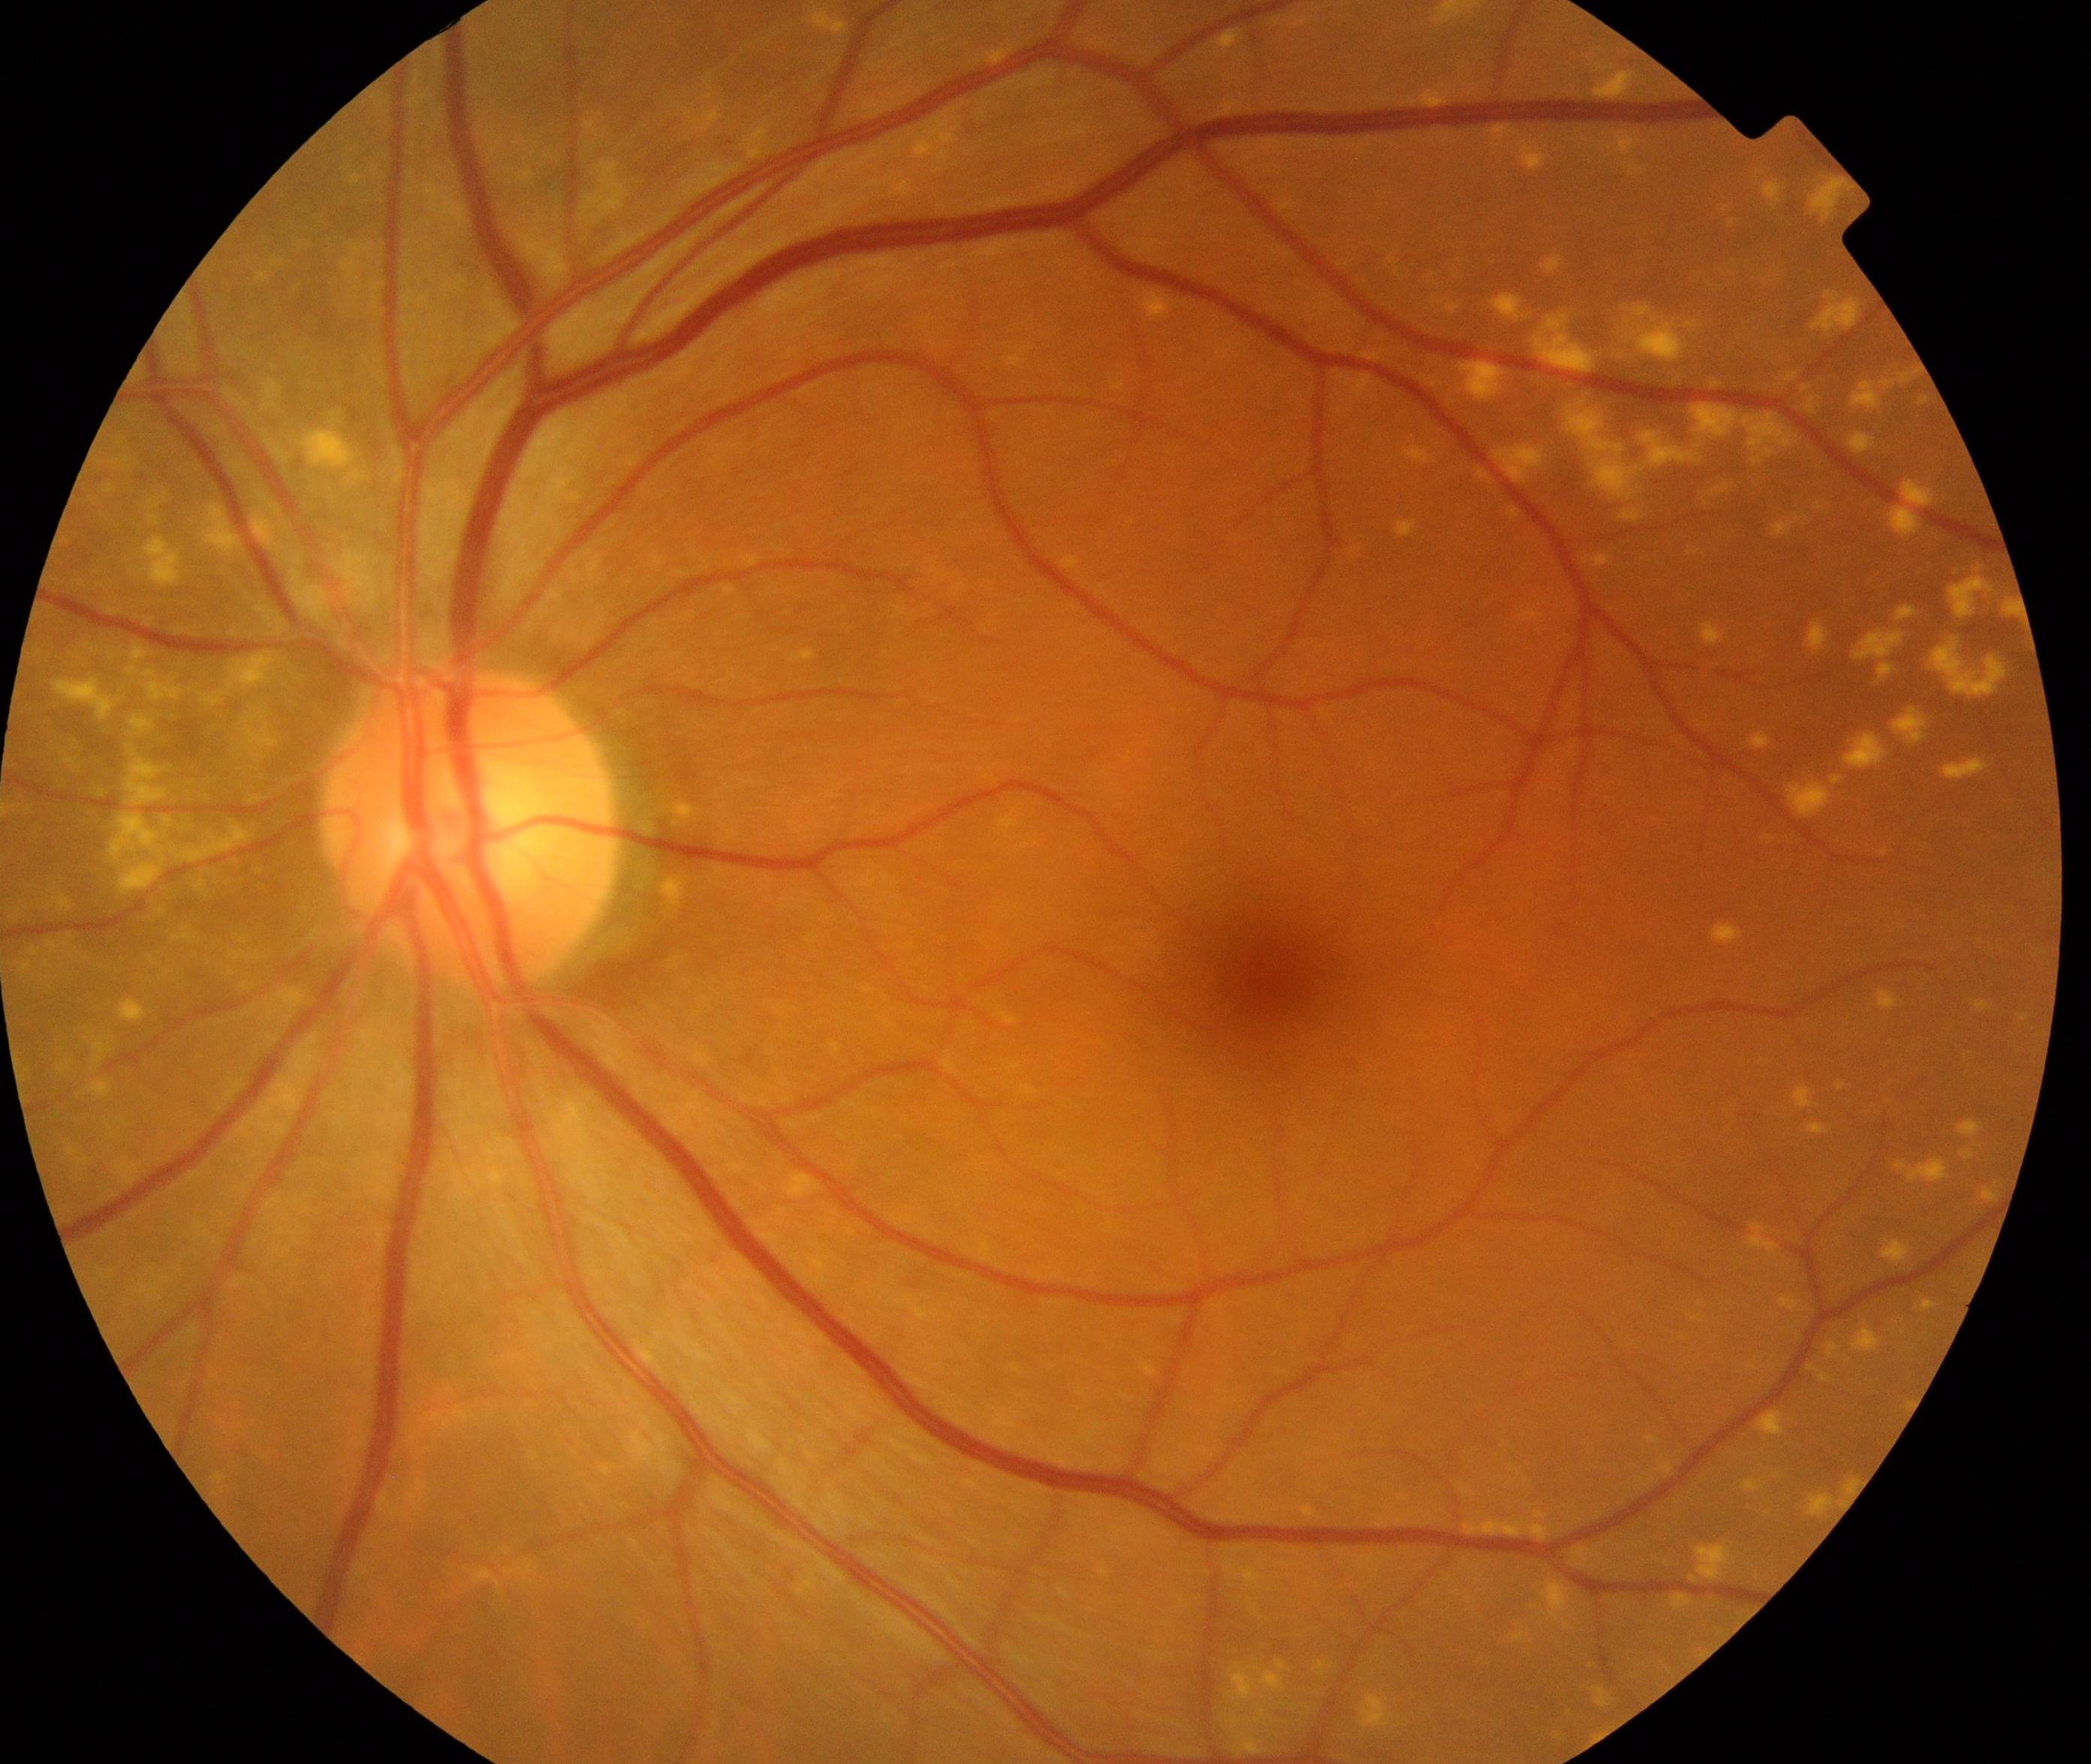
Classification: yellow-white spots or flecks.